2361 x 1568 pixels, 45° field of view — 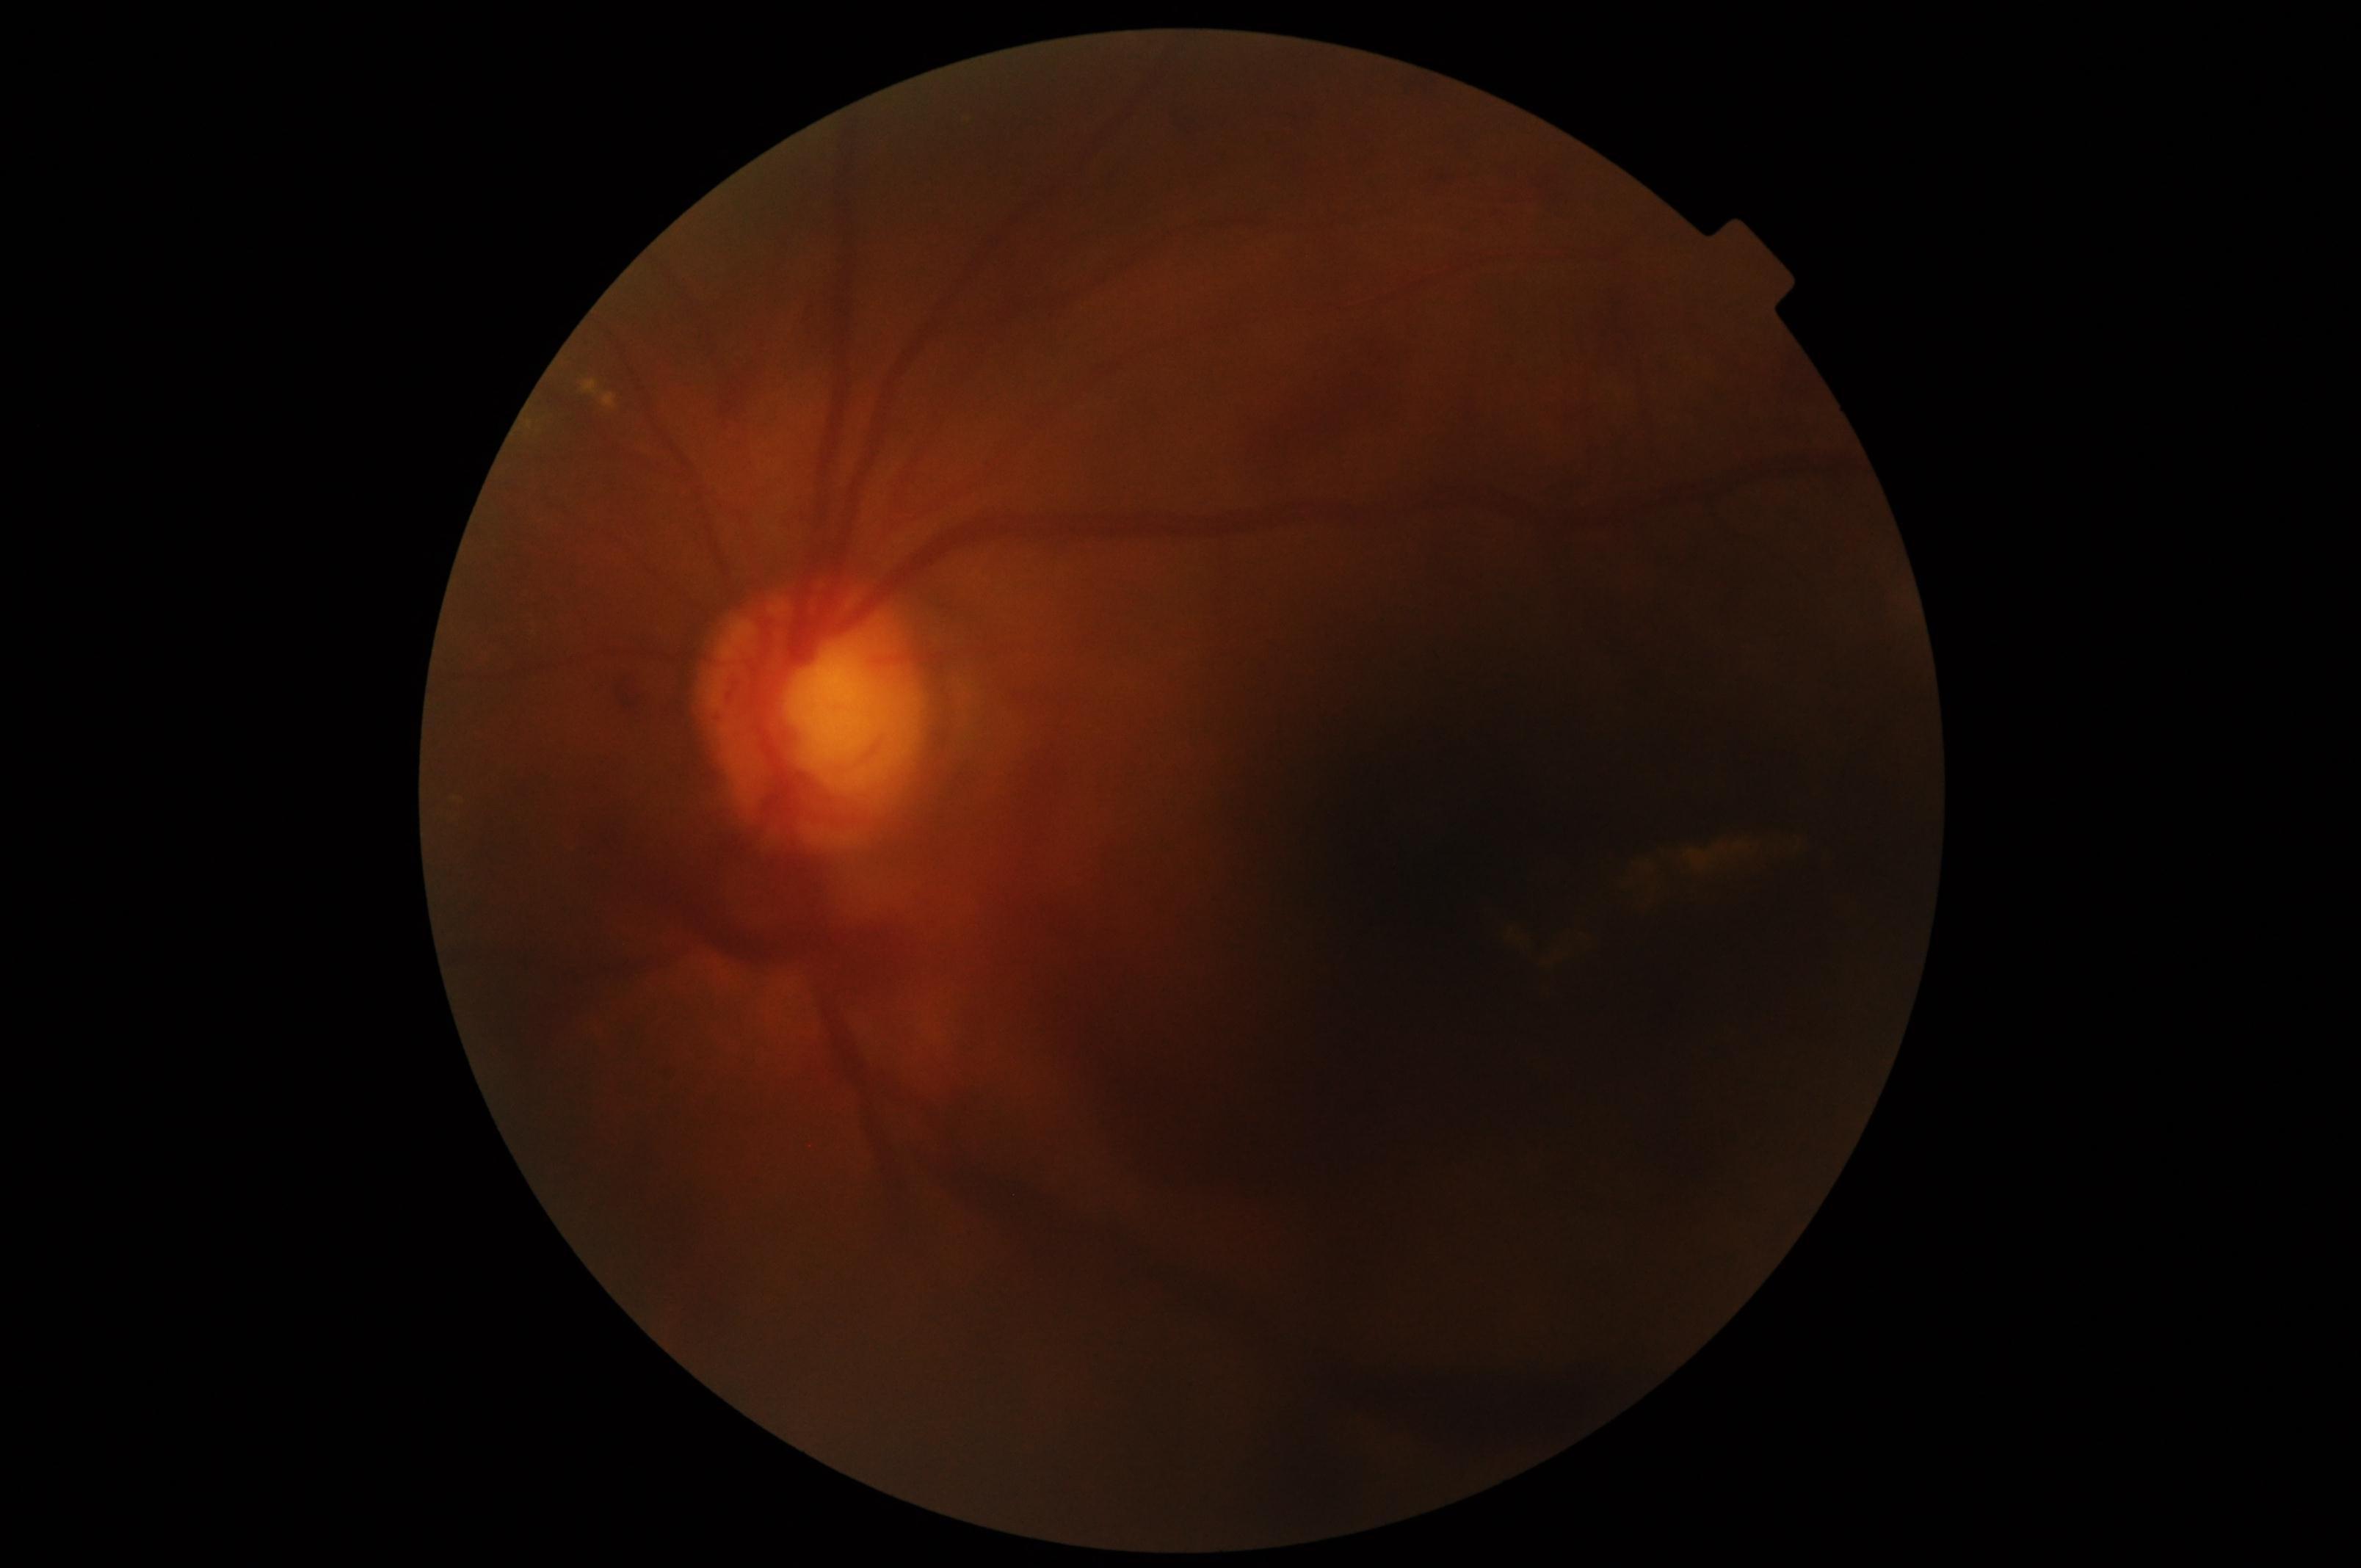 Diabetic retinopathy: 4. DR class: proliferative diabetic retinopathy.